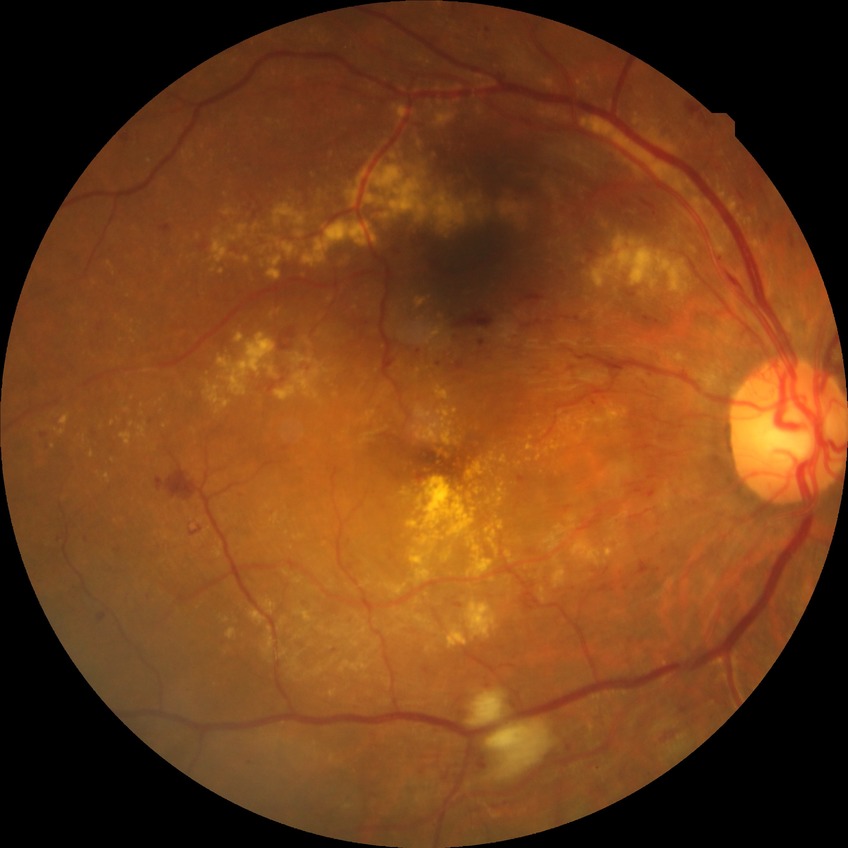 DR severity is PPDR.